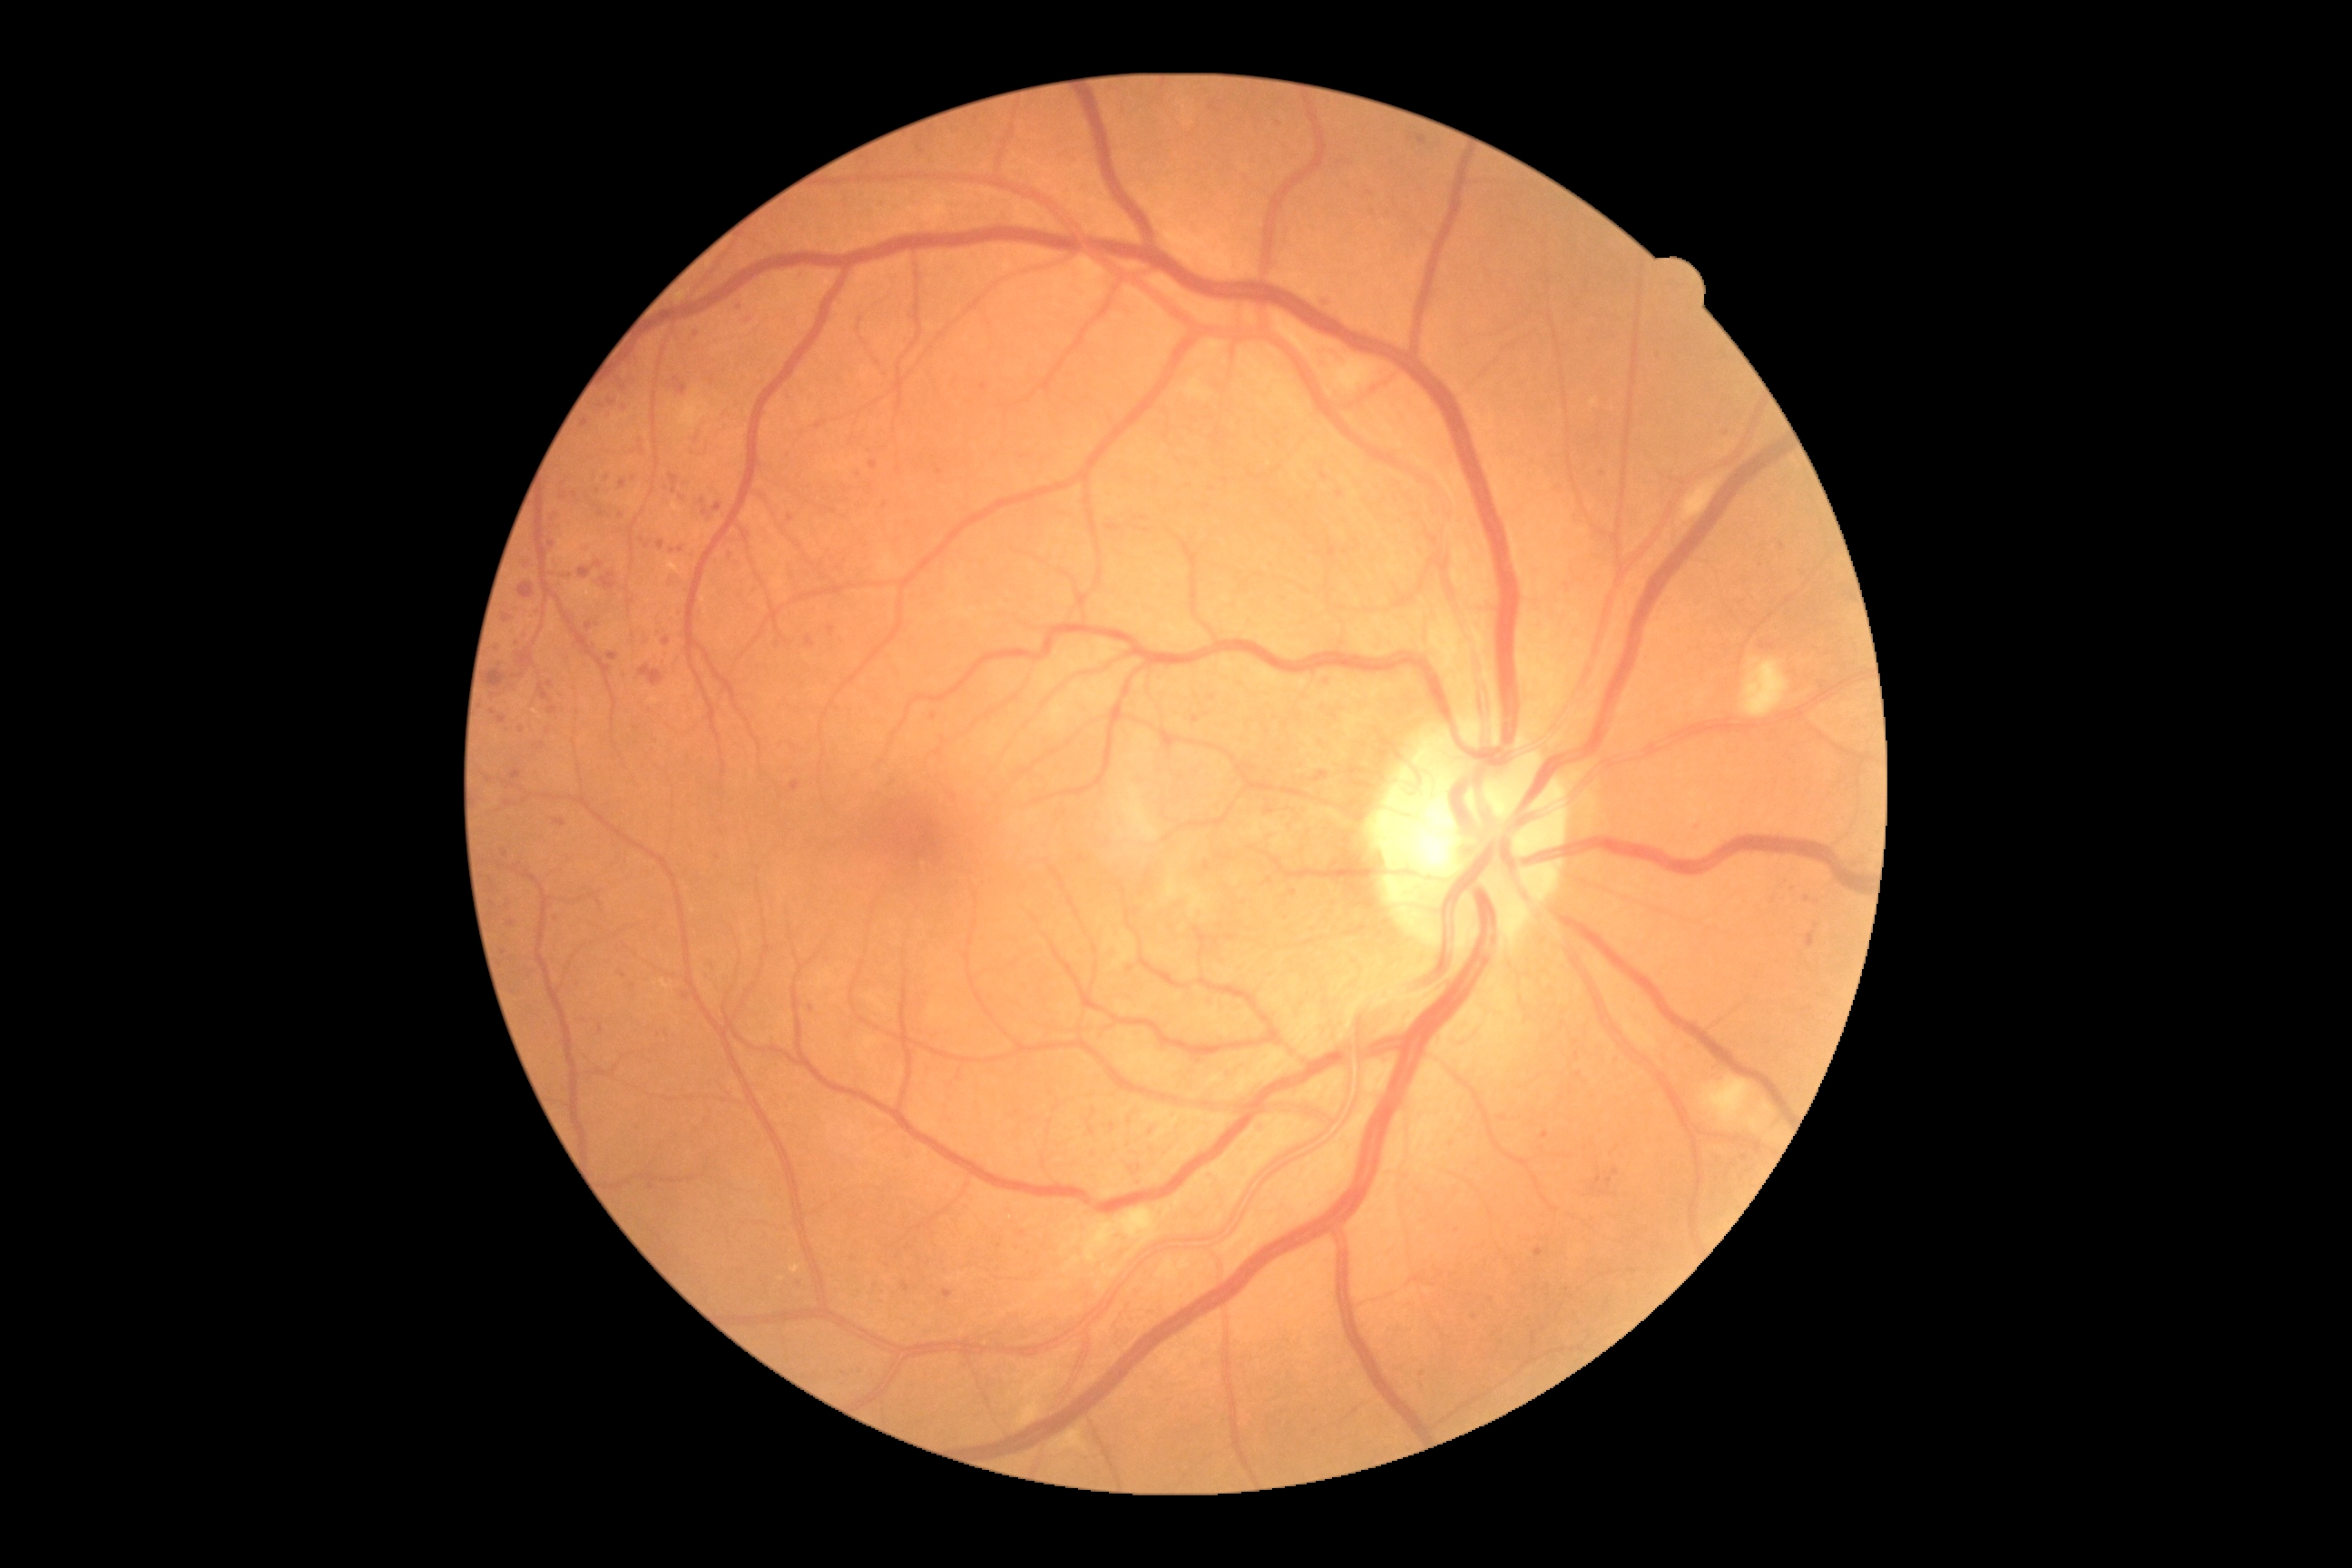

Diabetic retinopathy (DR): grade 2 (moderate NPDR)
Representative lesions:
microaneurysms (MAs) (continued) = (left=790, top=781, right=801, bottom=790); (left=489, top=877, right=495, bottom=885); (left=658, top=540, right=665, bottom=551); (left=587, top=622, right=593, bottom=631)
Smaller MAs around (541, 746); (673, 551); (854, 1258); (940, 472); (622, 516); (1057, 1109); (1422, 1375); (683, 498); (600, 903); (1746, 1158); (522, 730); (1726, 432); (796, 1282)